640 x 480 pixels · acquired on the Clarity RetCam 3 · wide-field fundus photograph from neonatal ROP screening.
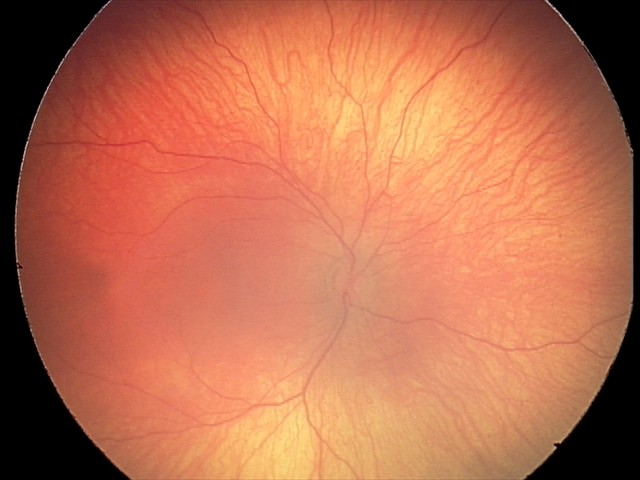 Assessment = physiological appearance.